45° field of view: 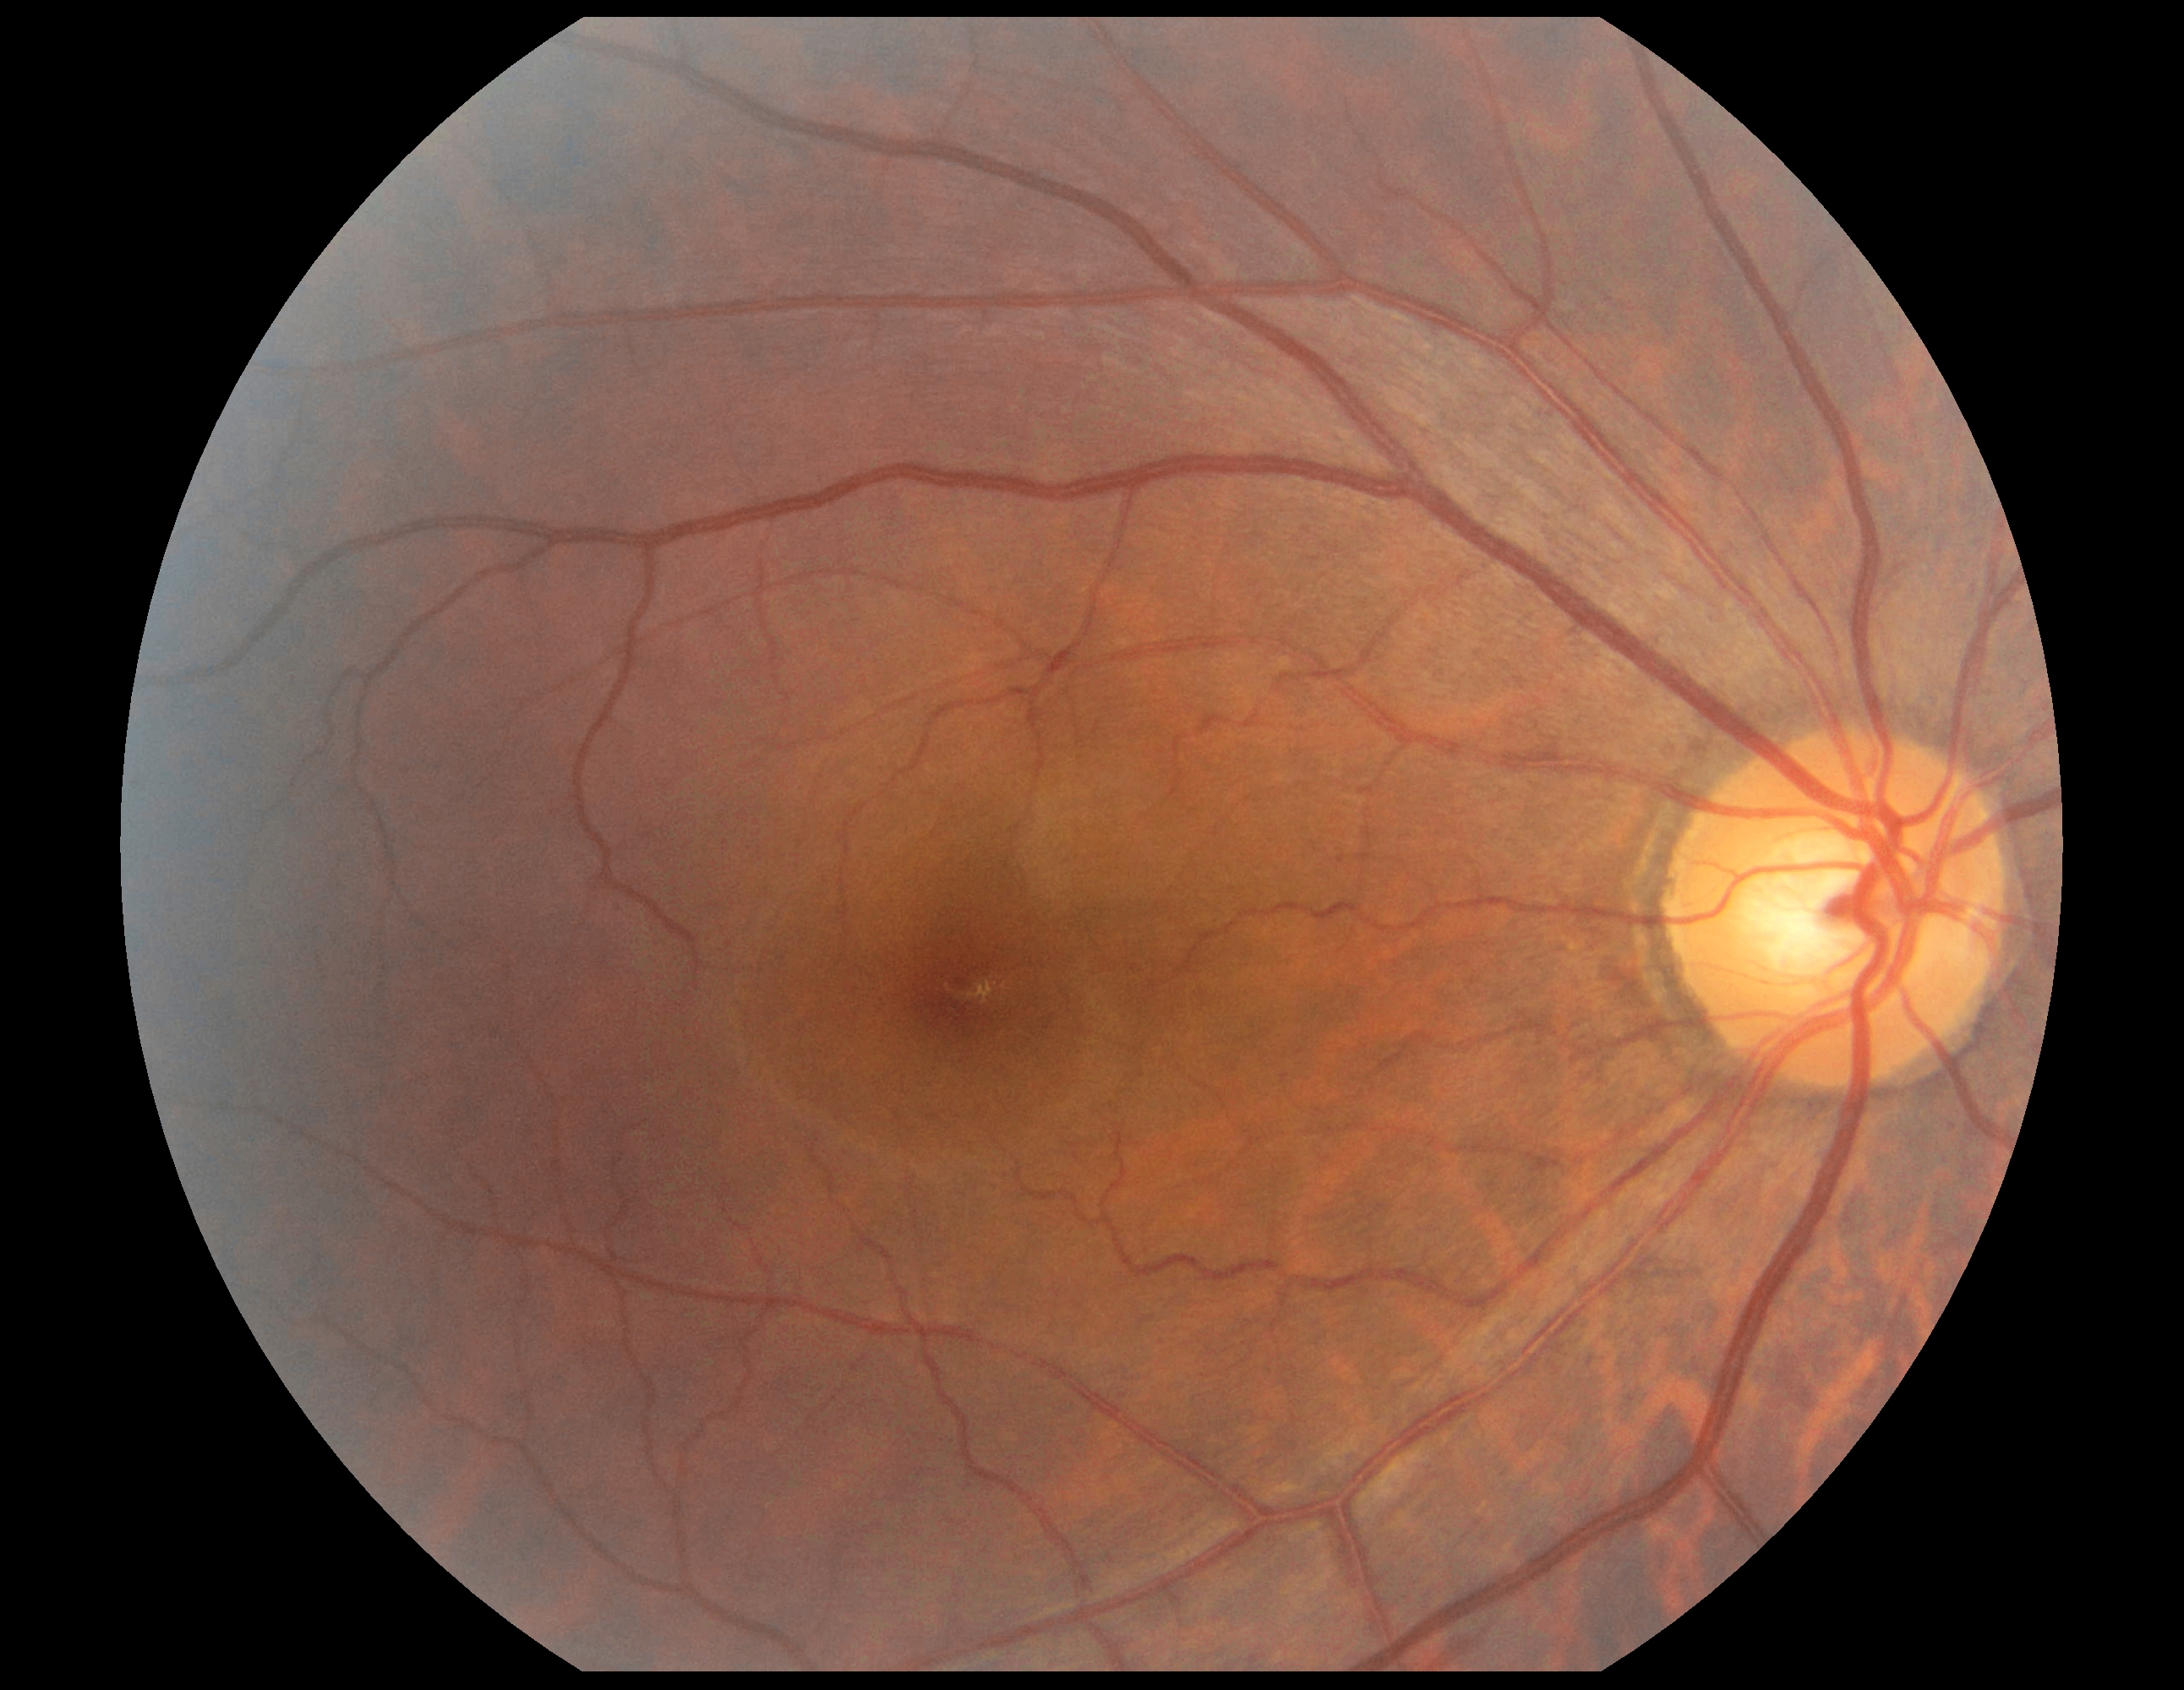

diabetic retinopathy (DR): grade 0 (no apparent retinopathy).